2048x1536, color fundus photograph:
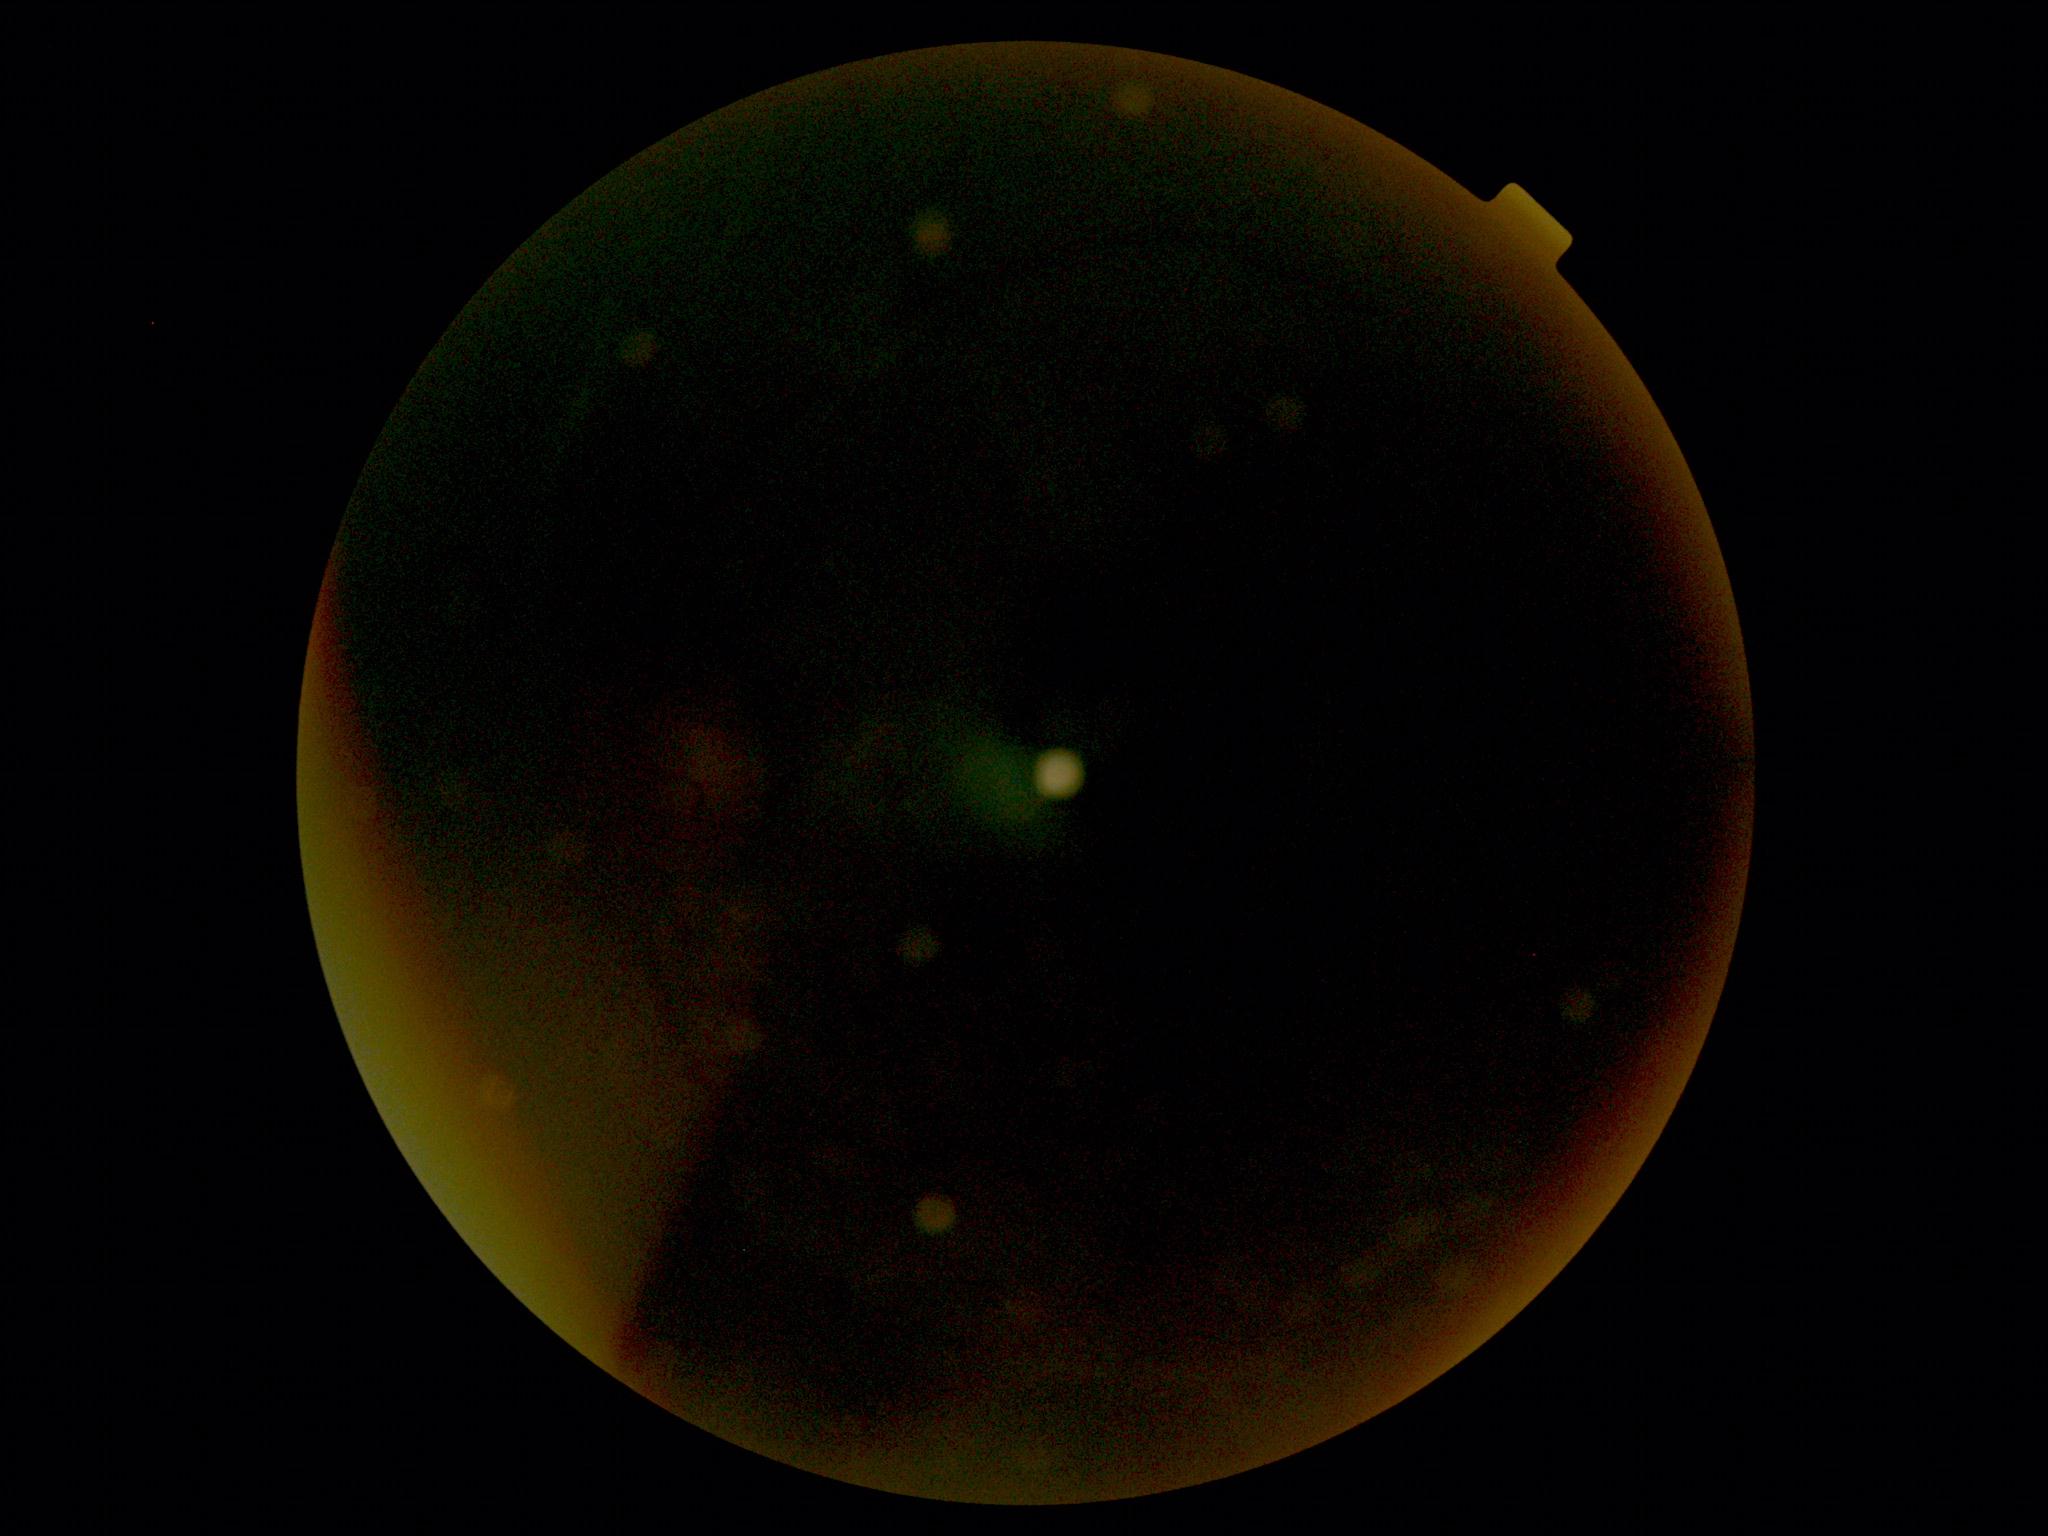
- DR stage — ungradable
- image quality — insufficient